Cropped to the optic nerve head.
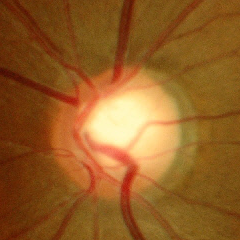 Q: What stage of glaucoma is present?
A: Yes — early glaucoma.